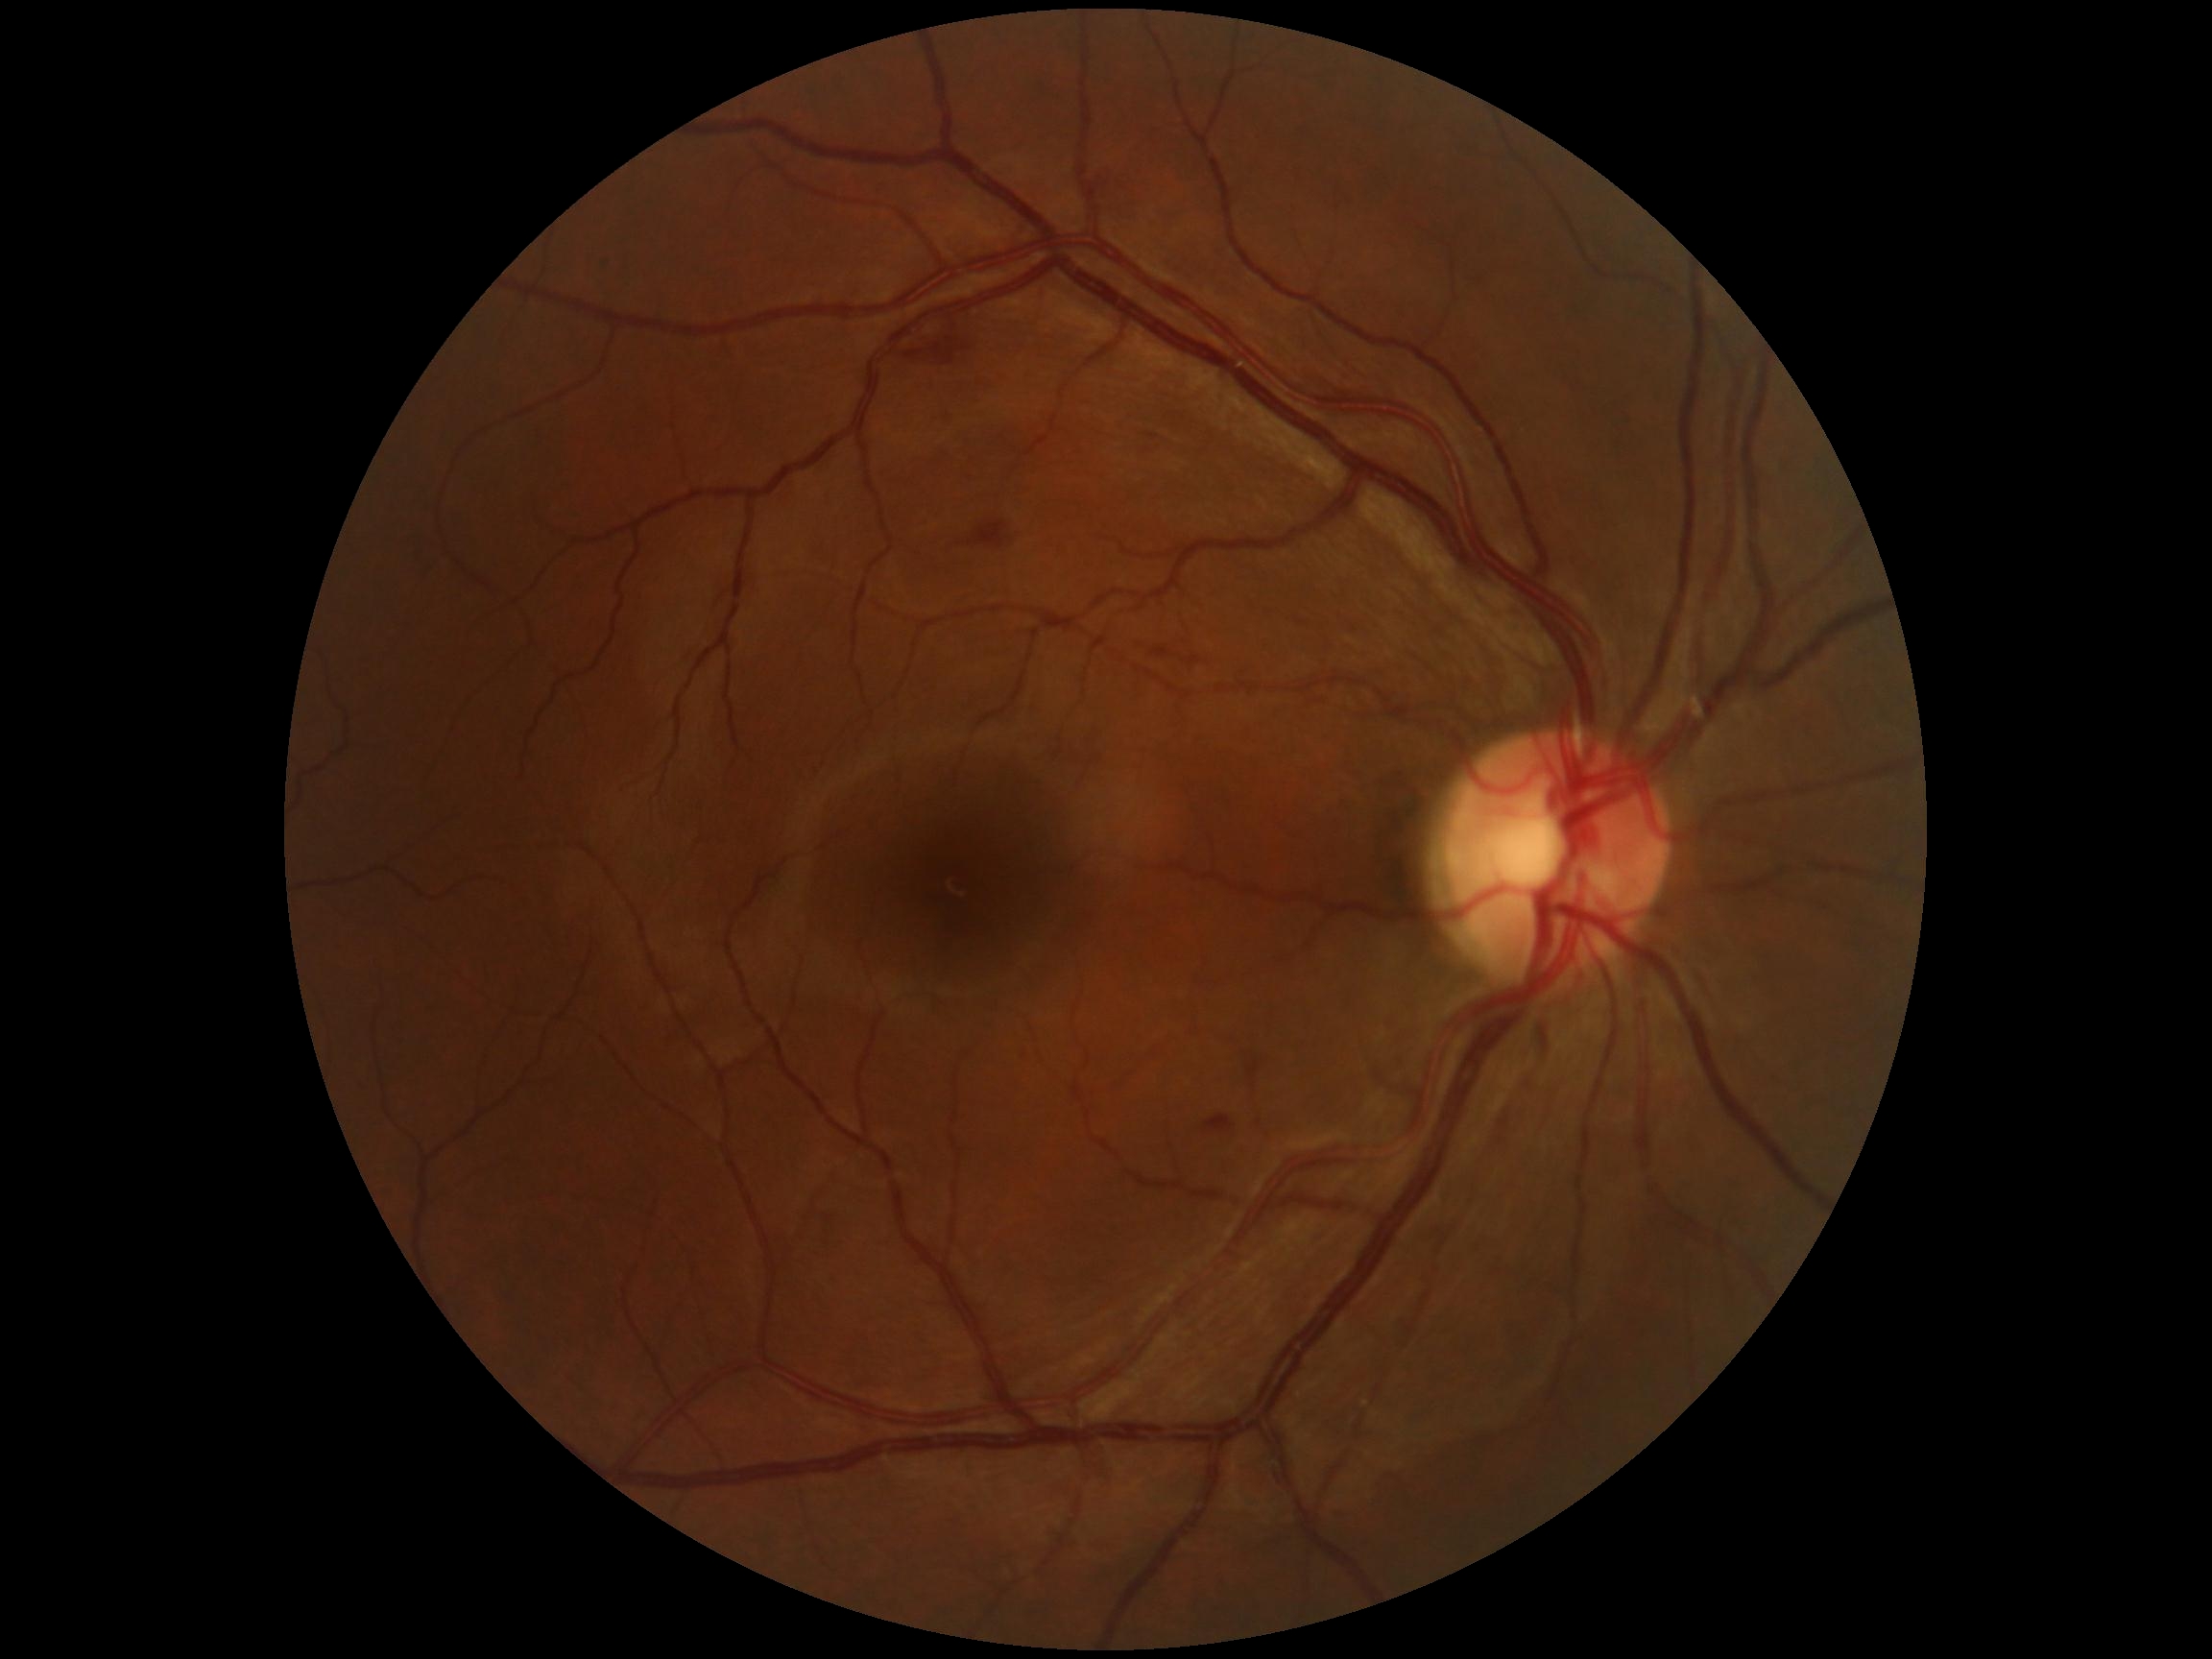 Diabetic retinopathy grade: 2/4. DR class: non-proliferative diabetic retinopathy.